Without pupil dilation. Camera: NIDEK AFC-230.
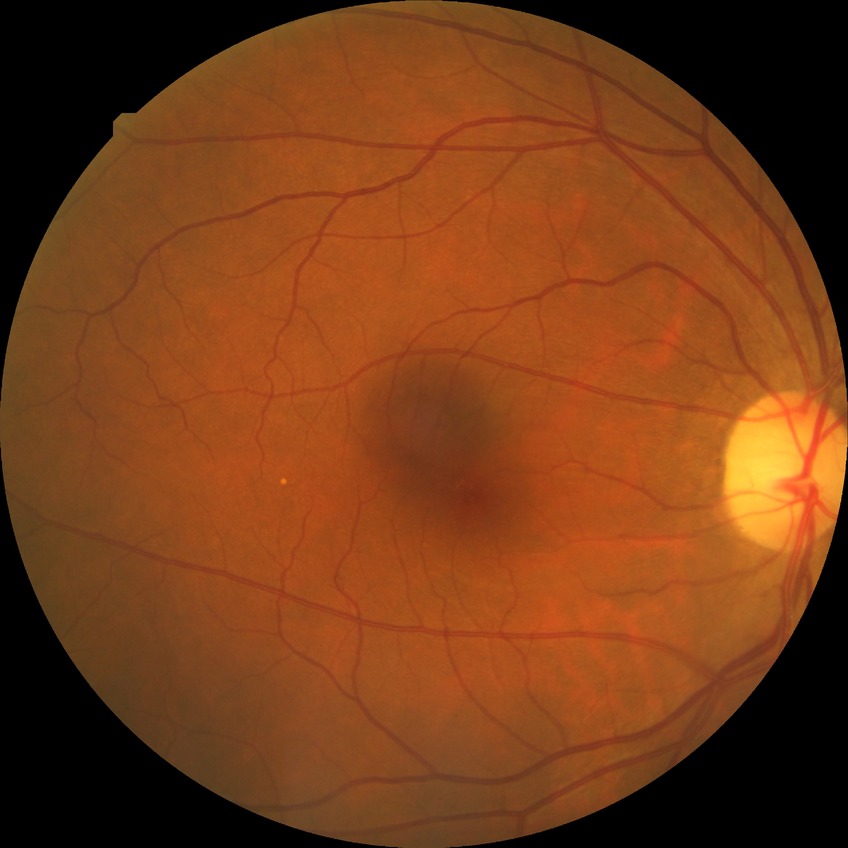 {
  "davis_grade": "no diabetic retinopathy (NDR)"
}